Phoenix ICON, 100° FOV. Pediatric retinal photograph (wide-field).
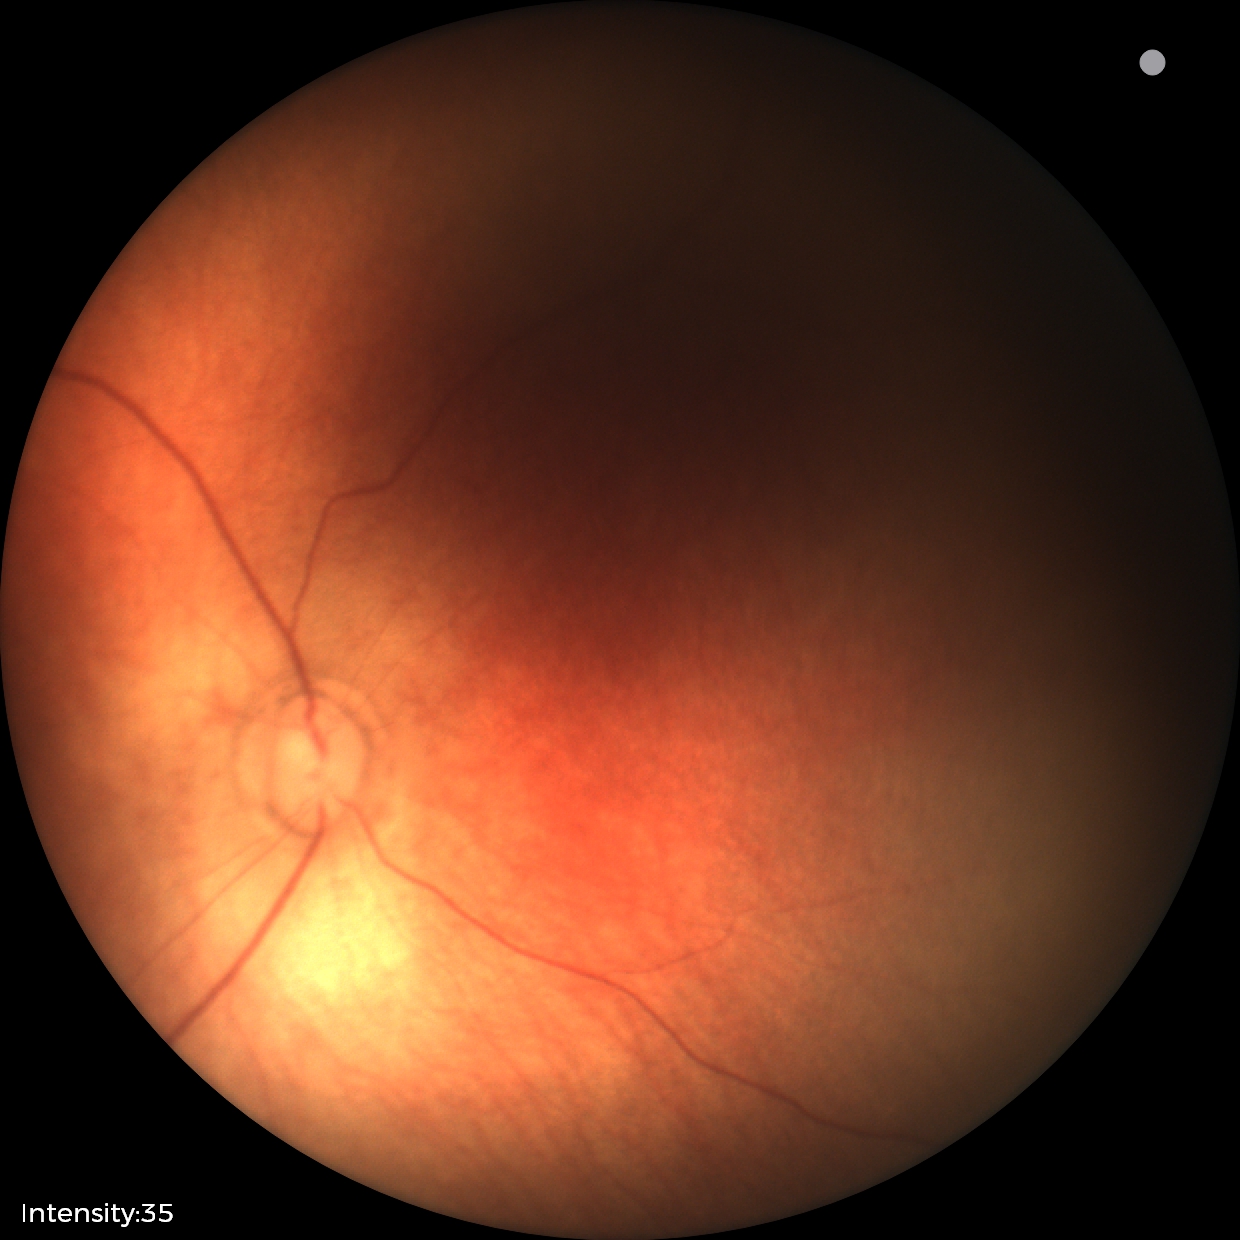
Physiological retinal appearance for postconceptual age.